45° field of view
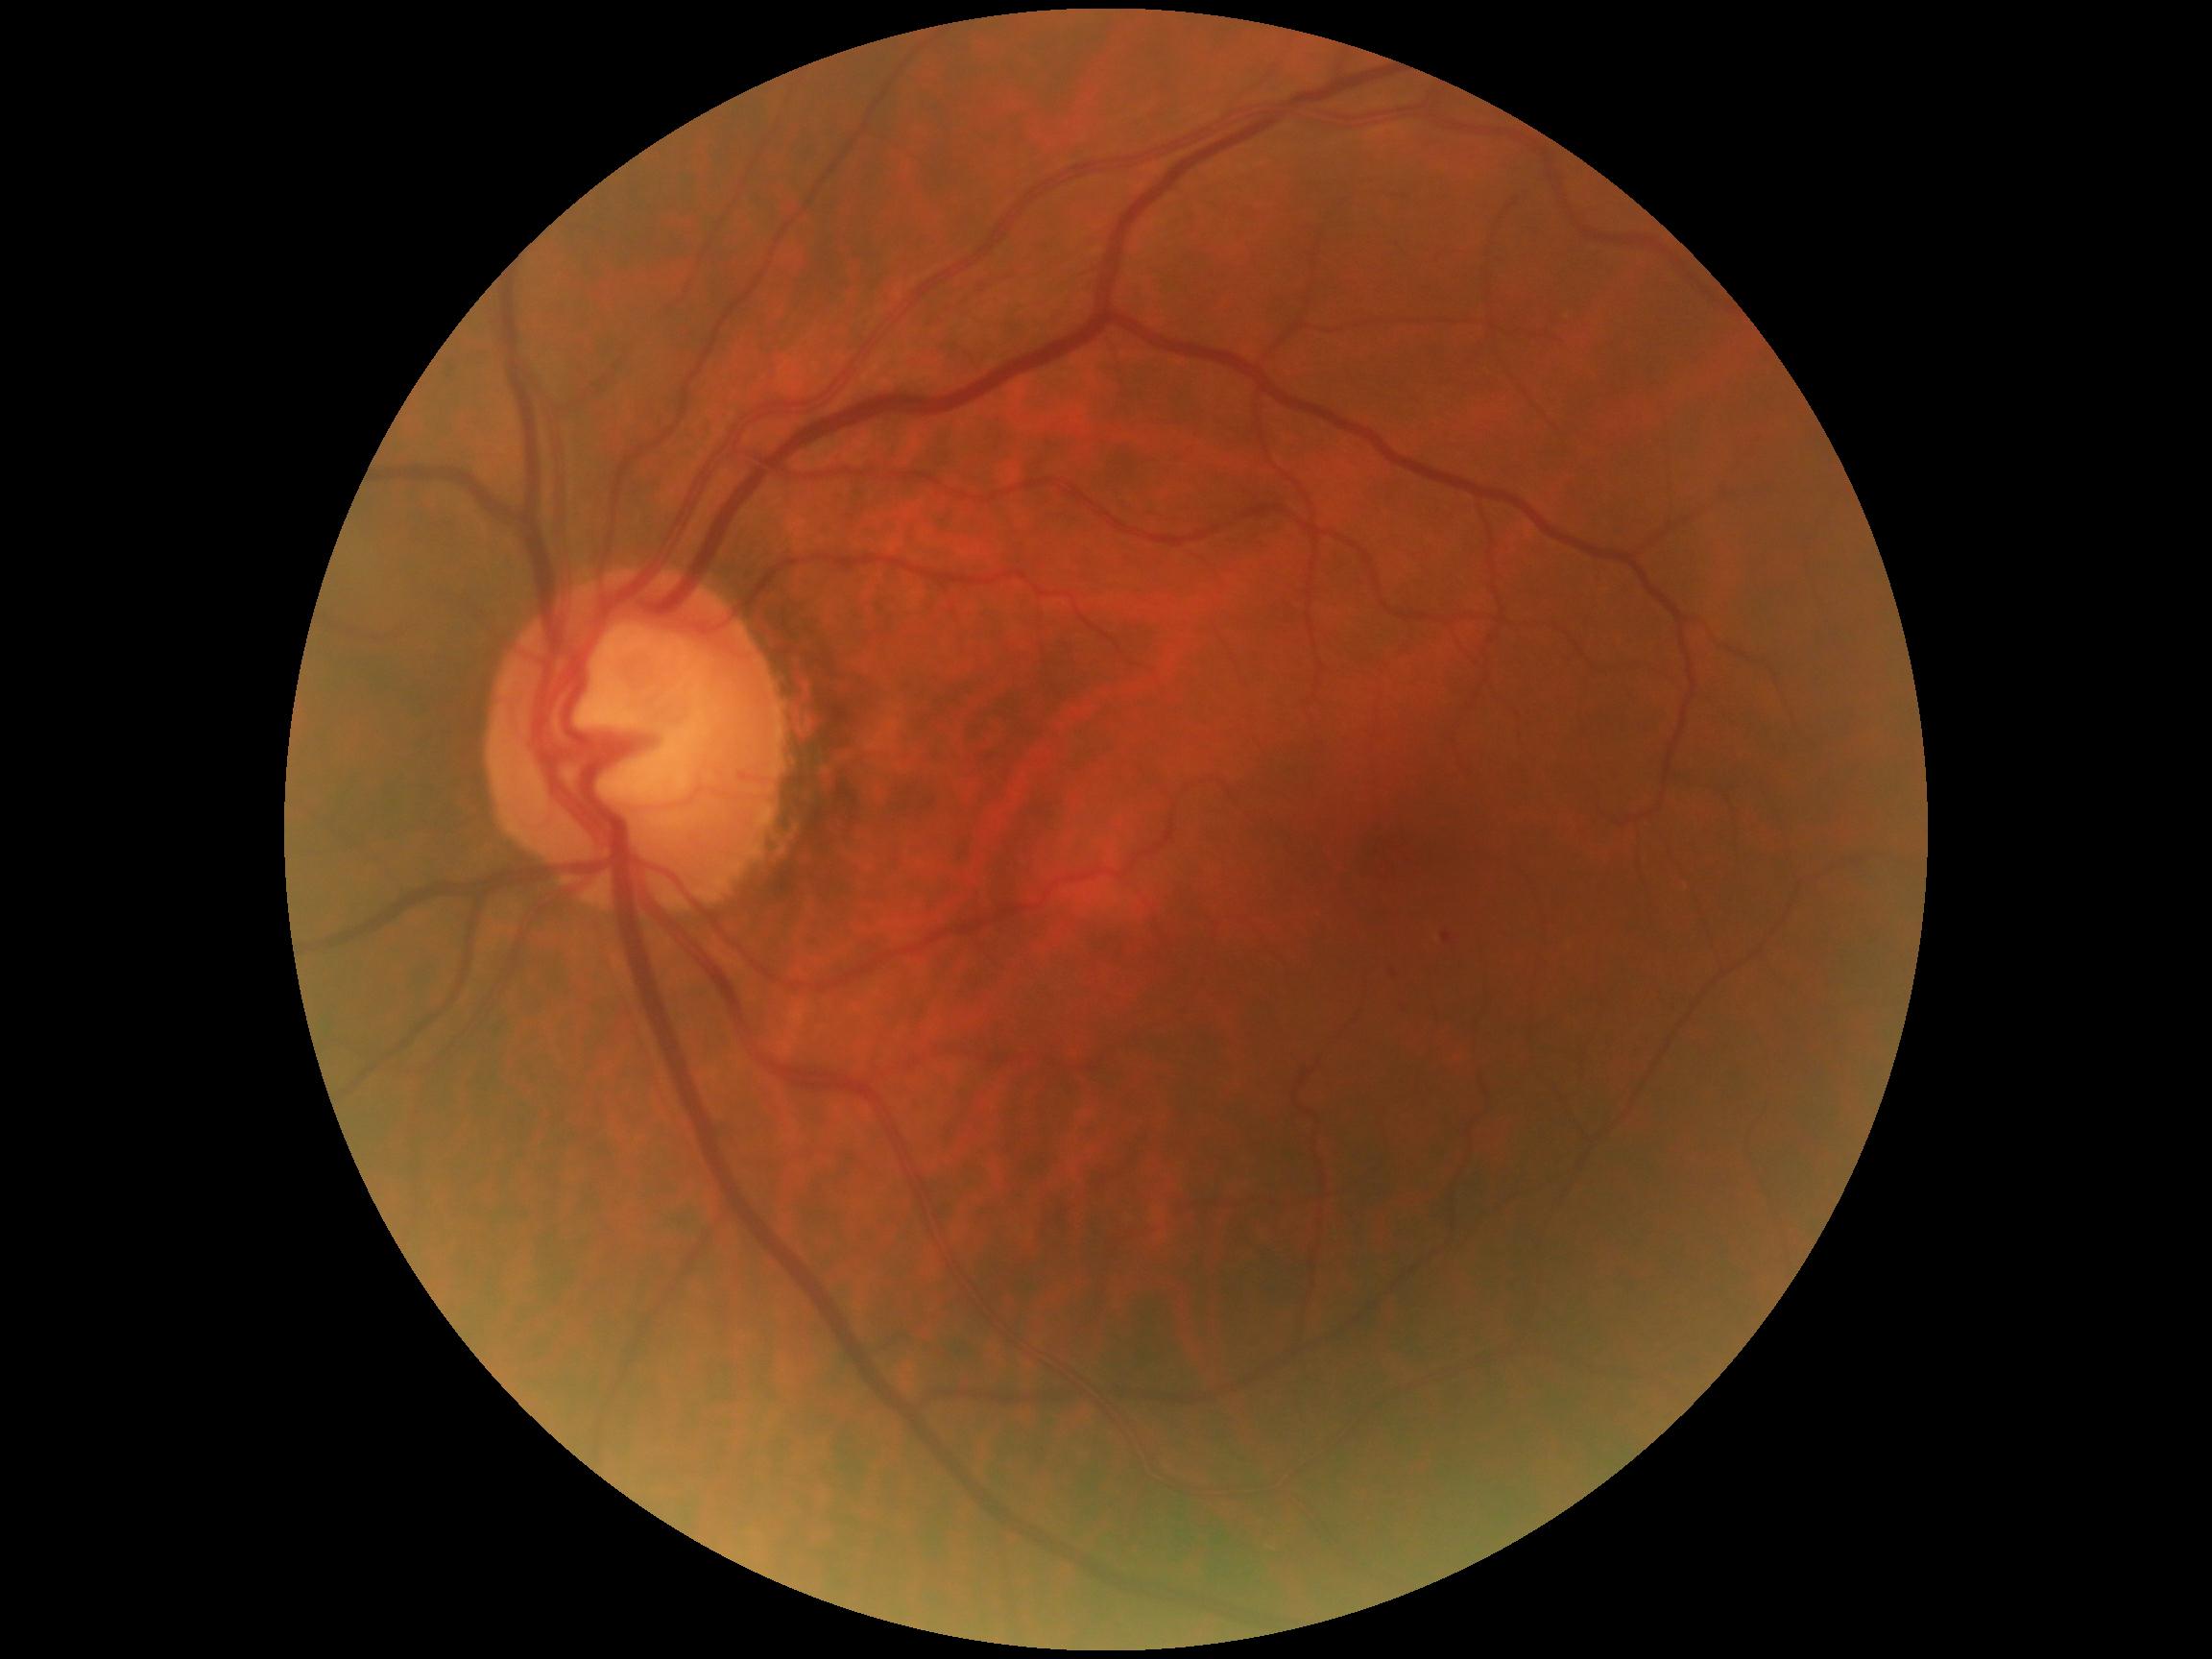

Diabetic retinopathy severity: 1.